640 by 480 pixels; pediatric retinal photograph (wide-field)
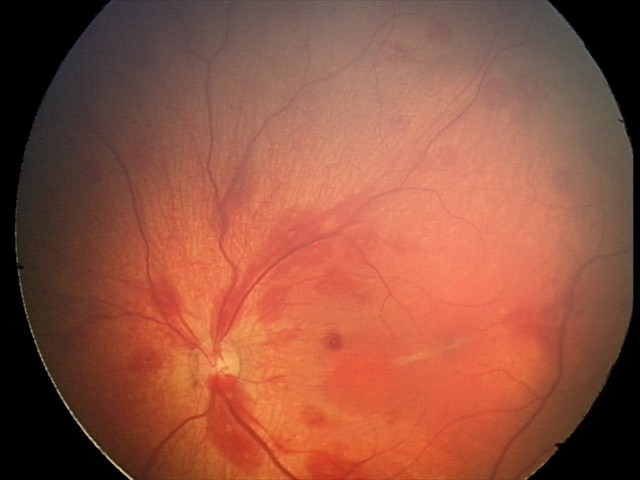
Diagnosis from this screening exam: retinal hemorrhages.